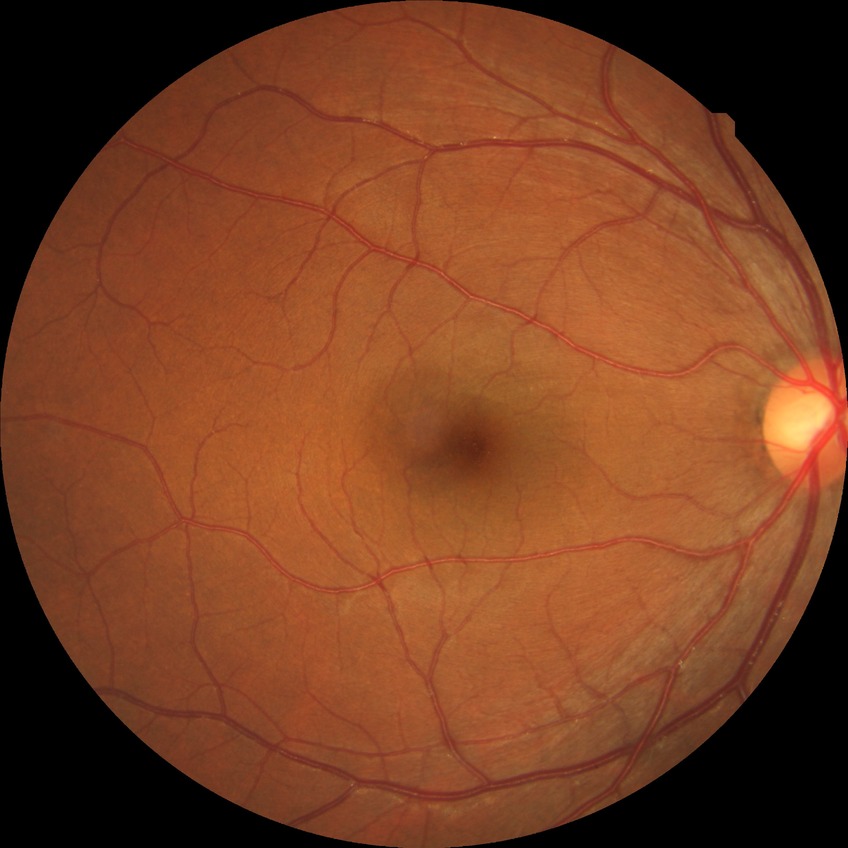
diabetic retinopathy (DR)@no diabetic retinopathy (NDR).